45° FOV.
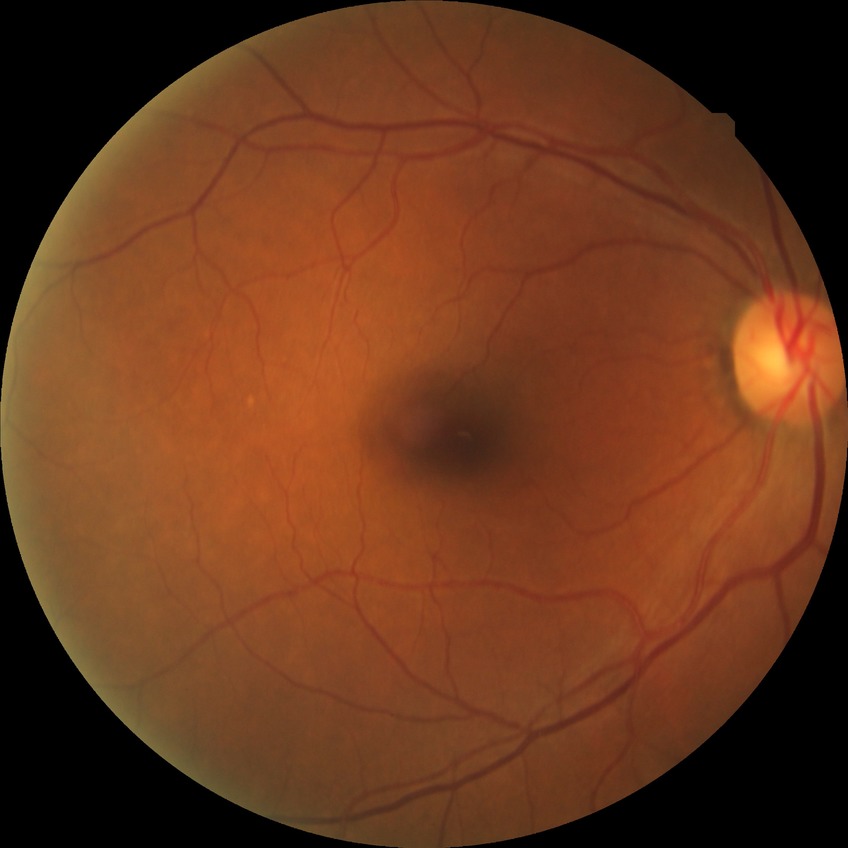 Davis DR grade is NDR.